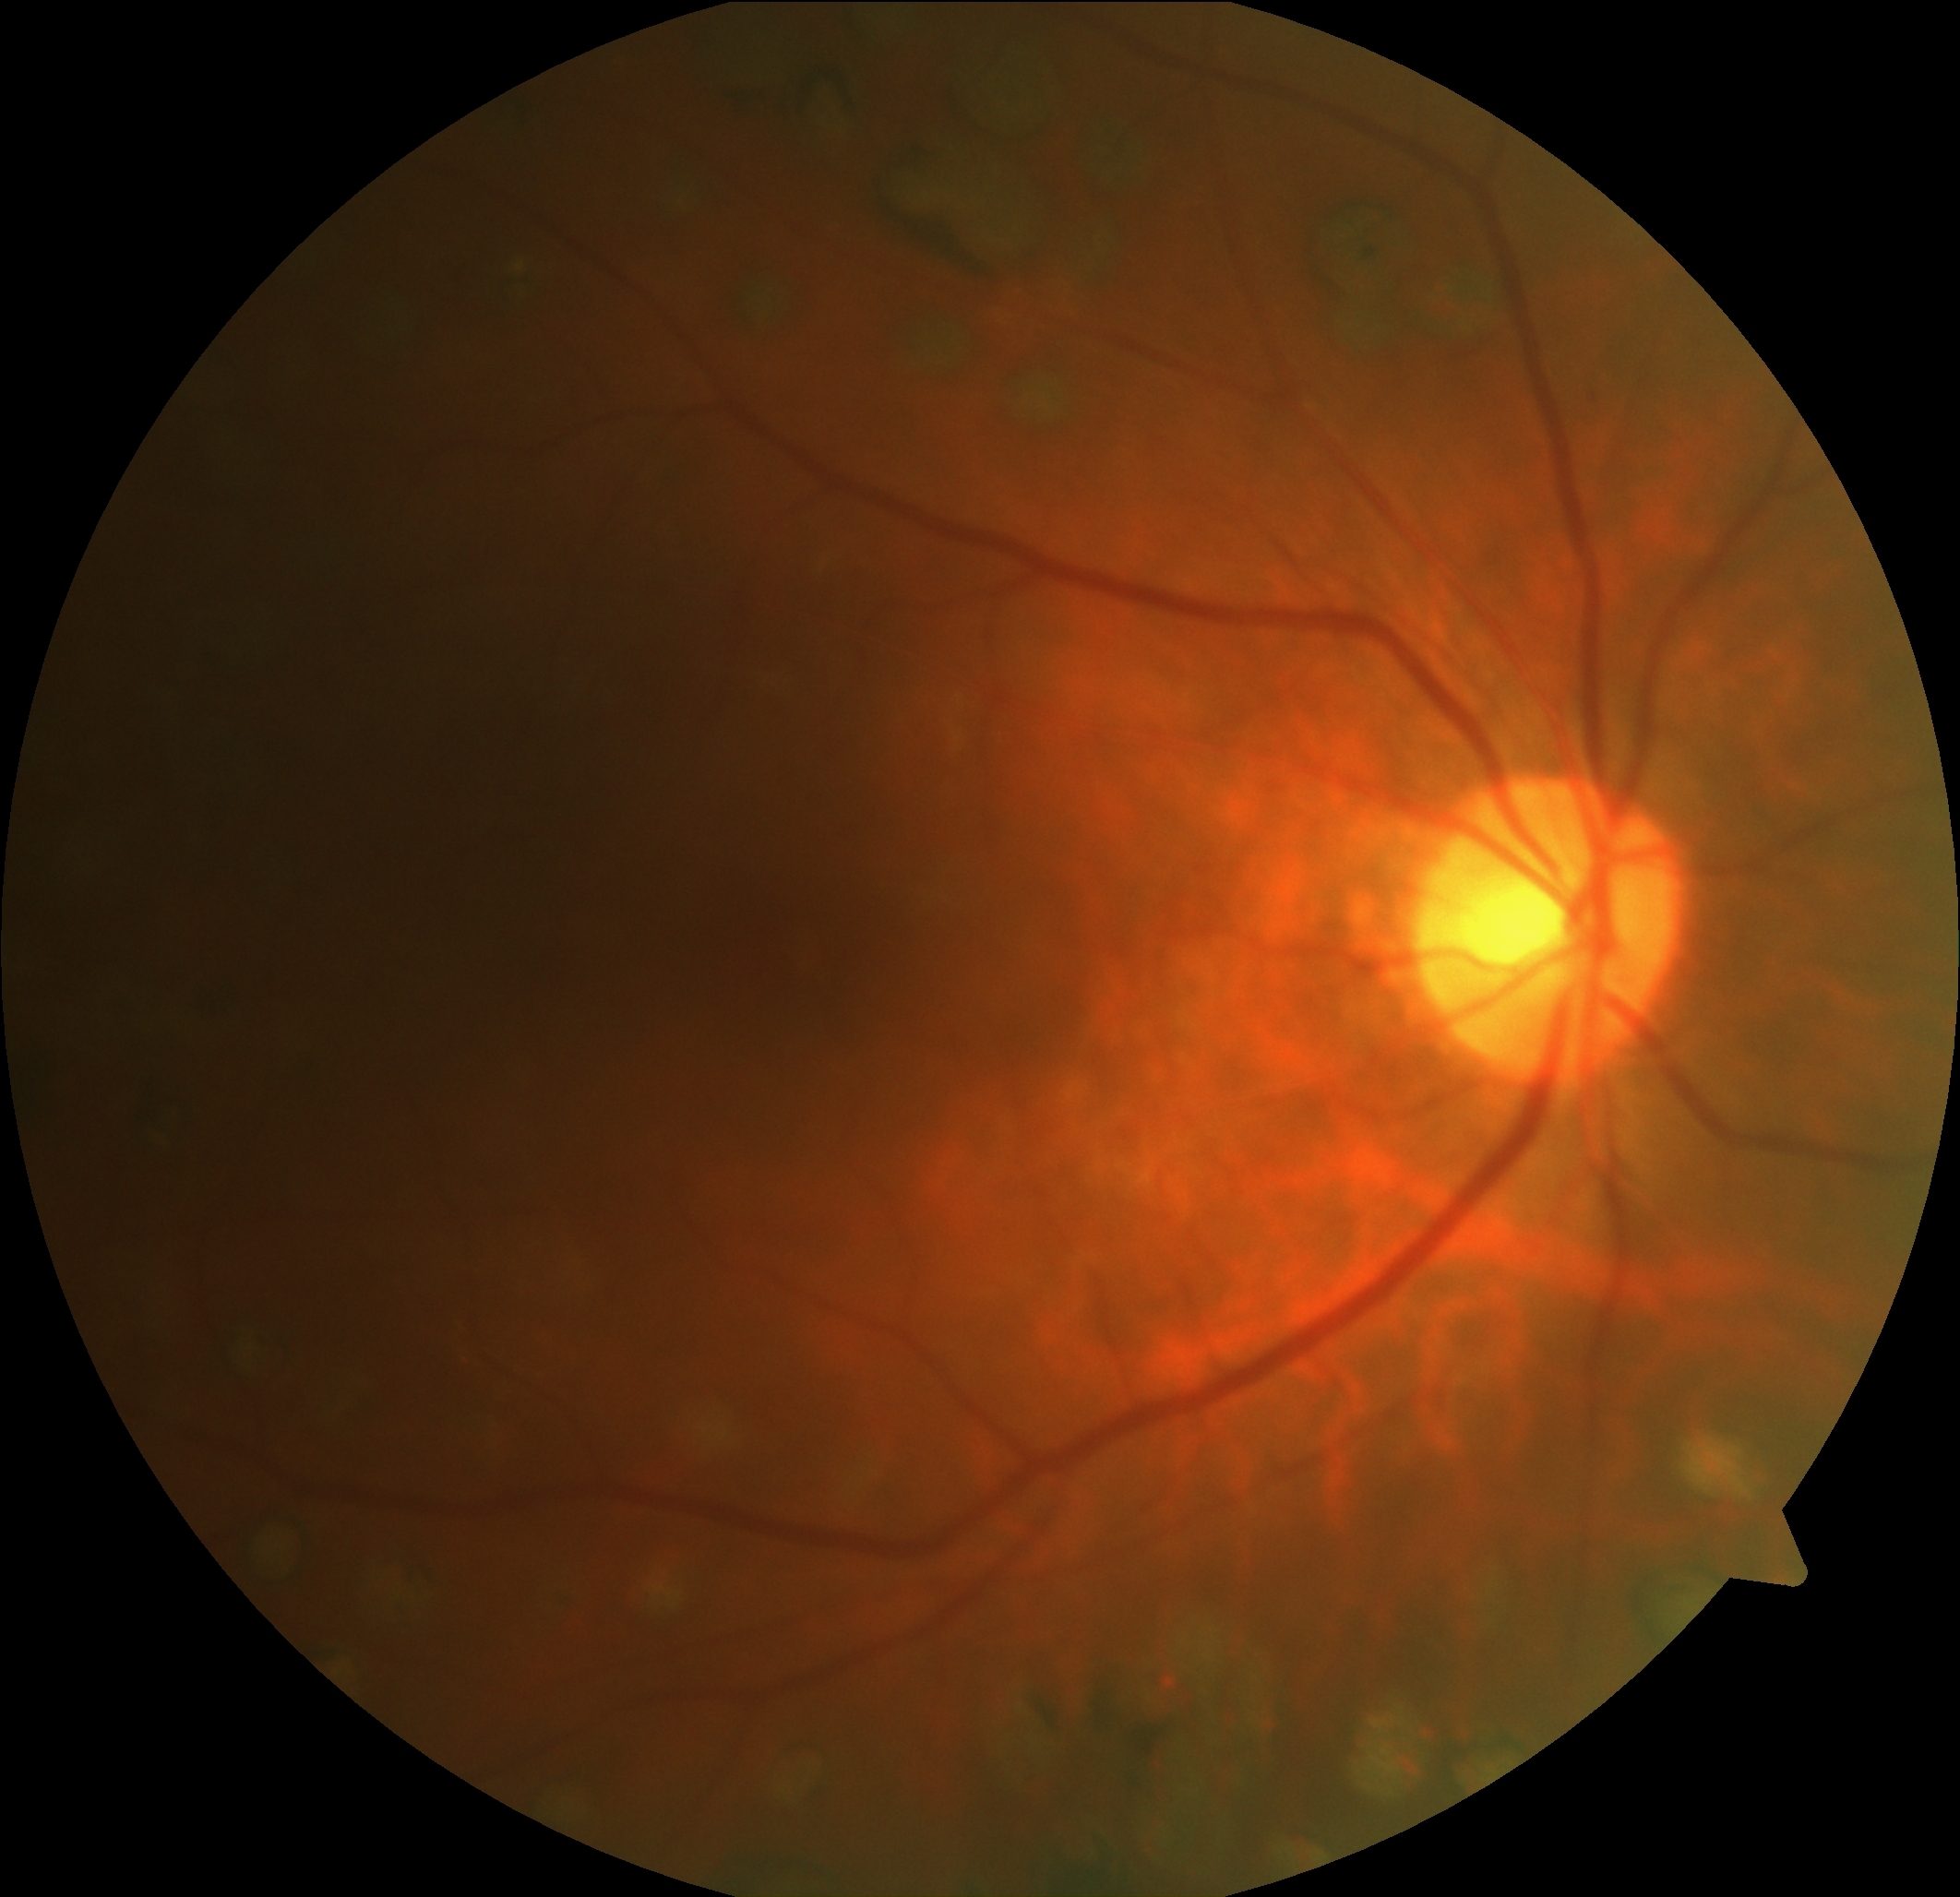

DR impression: no apparent DR, DR severity: grade 0 (no apparent retinopathy) — no visible signs of diabetic retinopathy.